FOV: 45 degrees. 2352 x 1568 pixels:
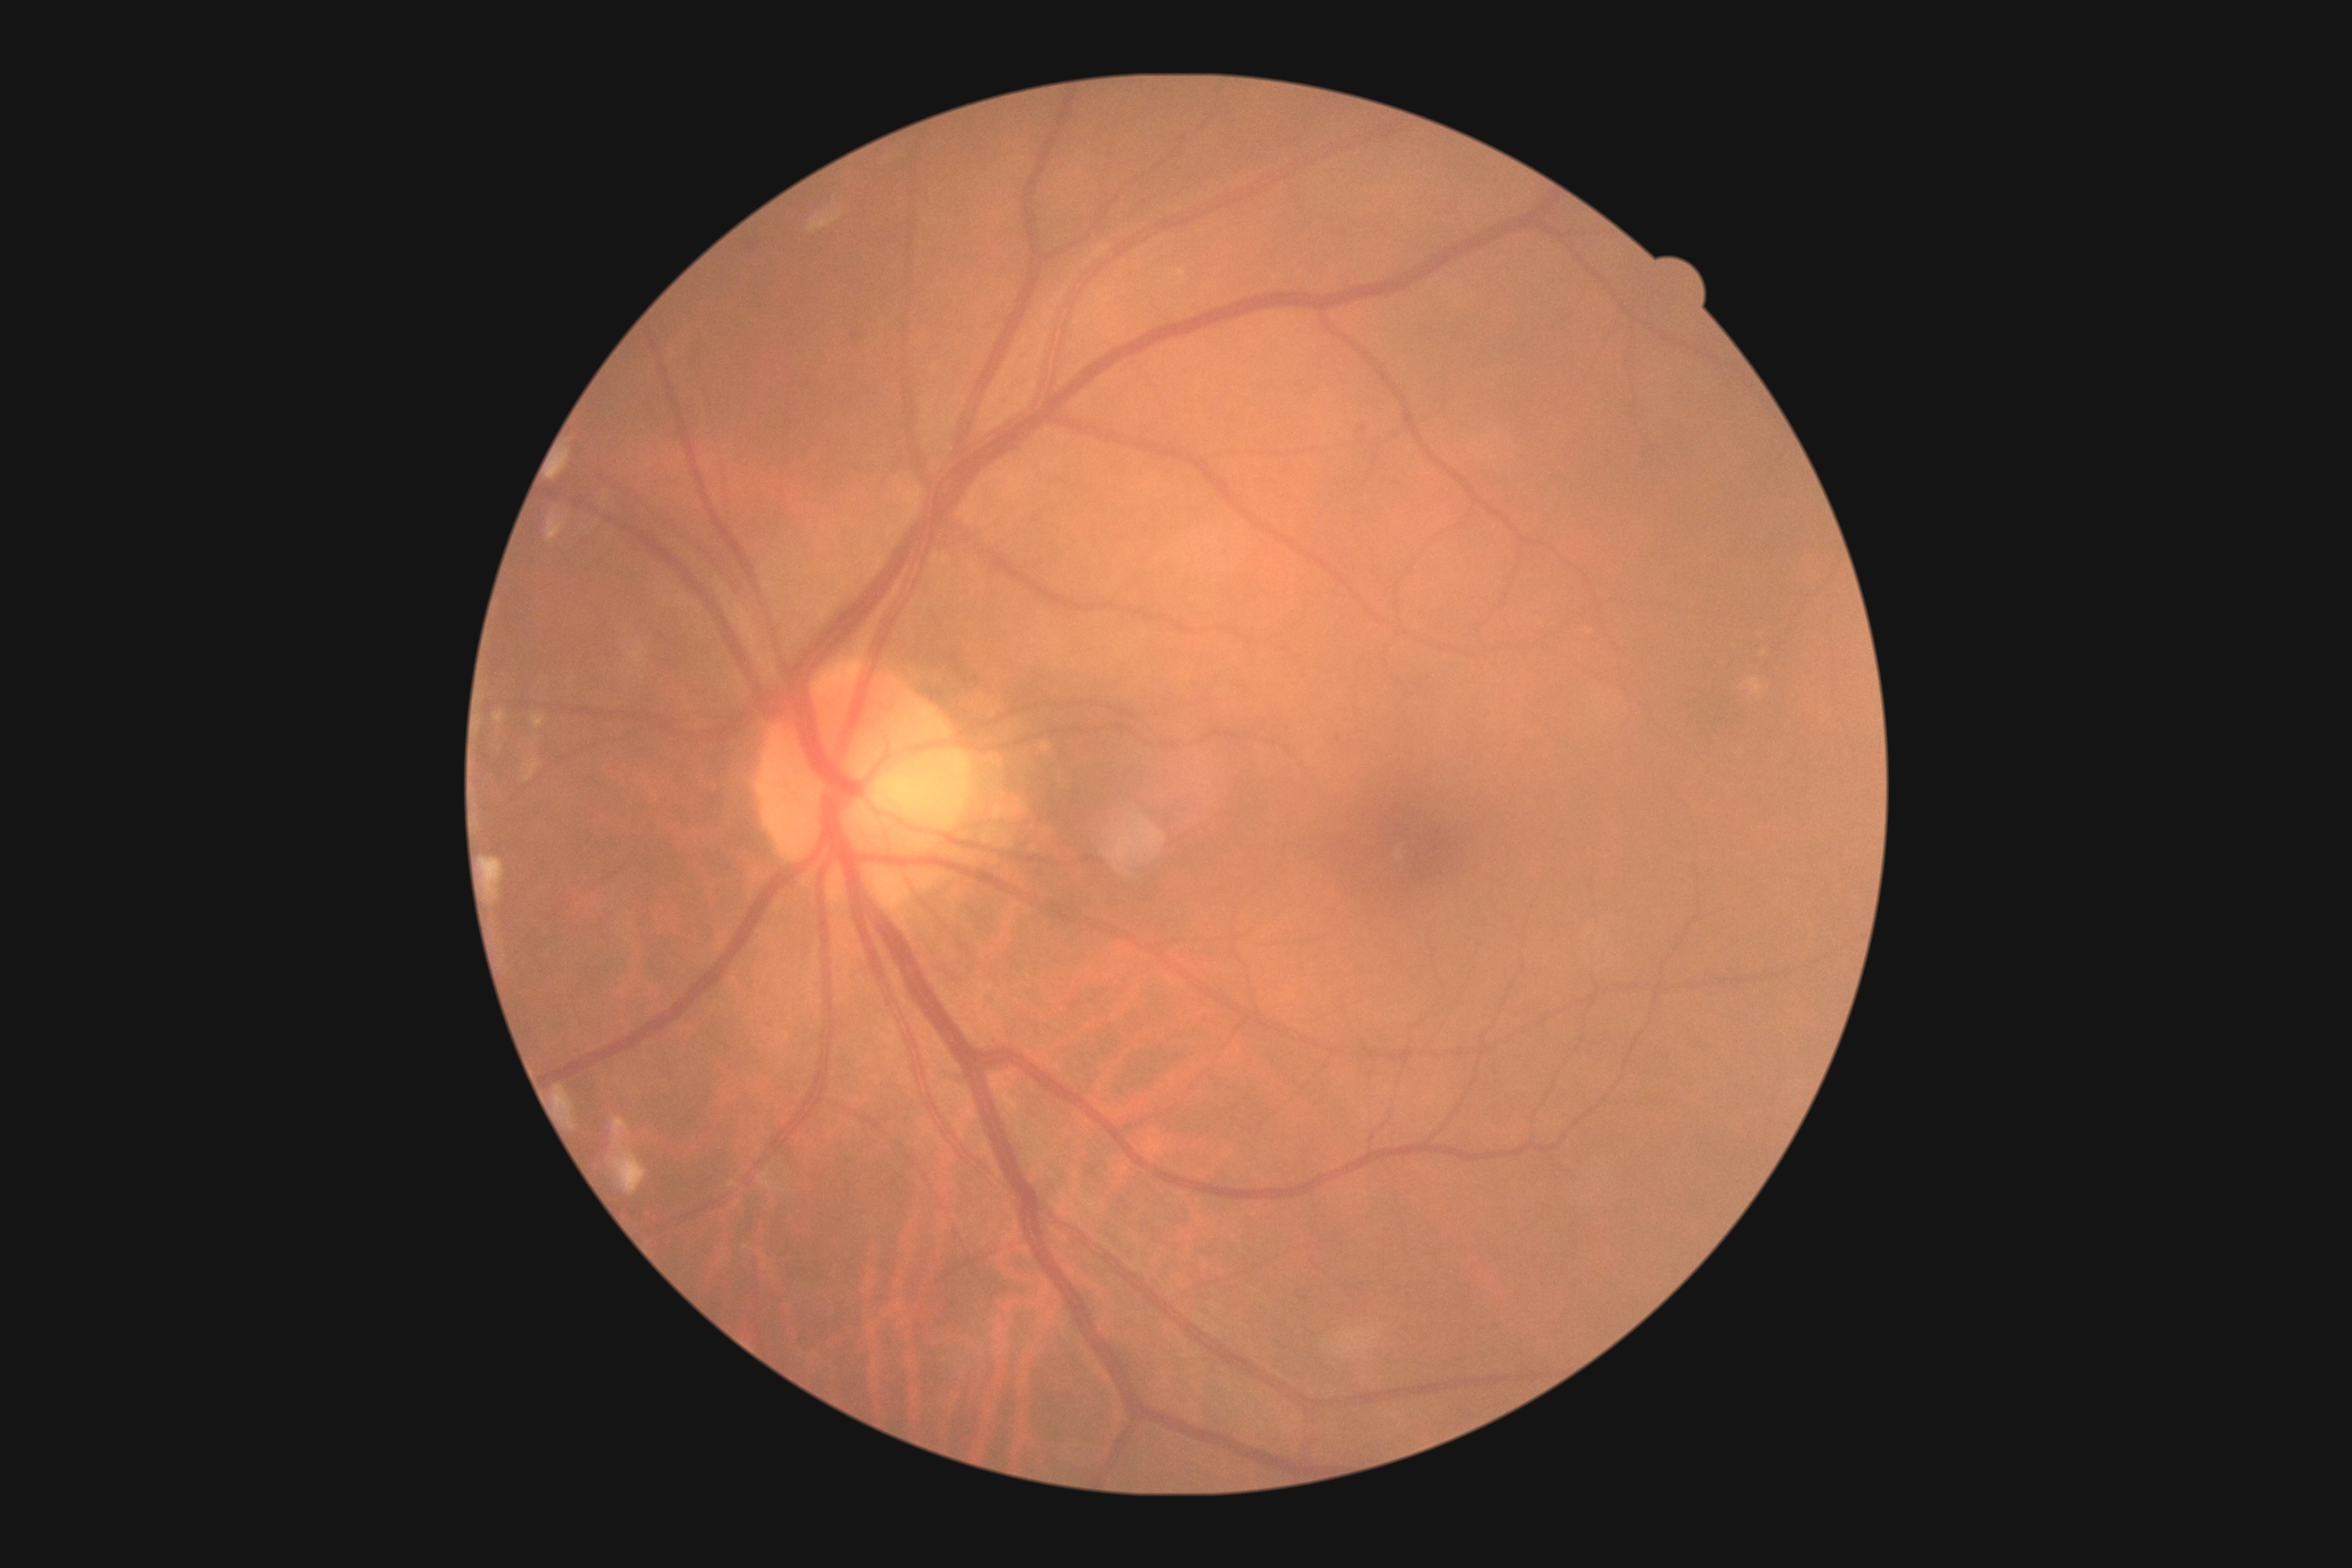
Diabetic retinopathy (DR): 1 — presence of microaneurysms only.